Image size 1240x1240; wide-field fundus image from infant ROP screening
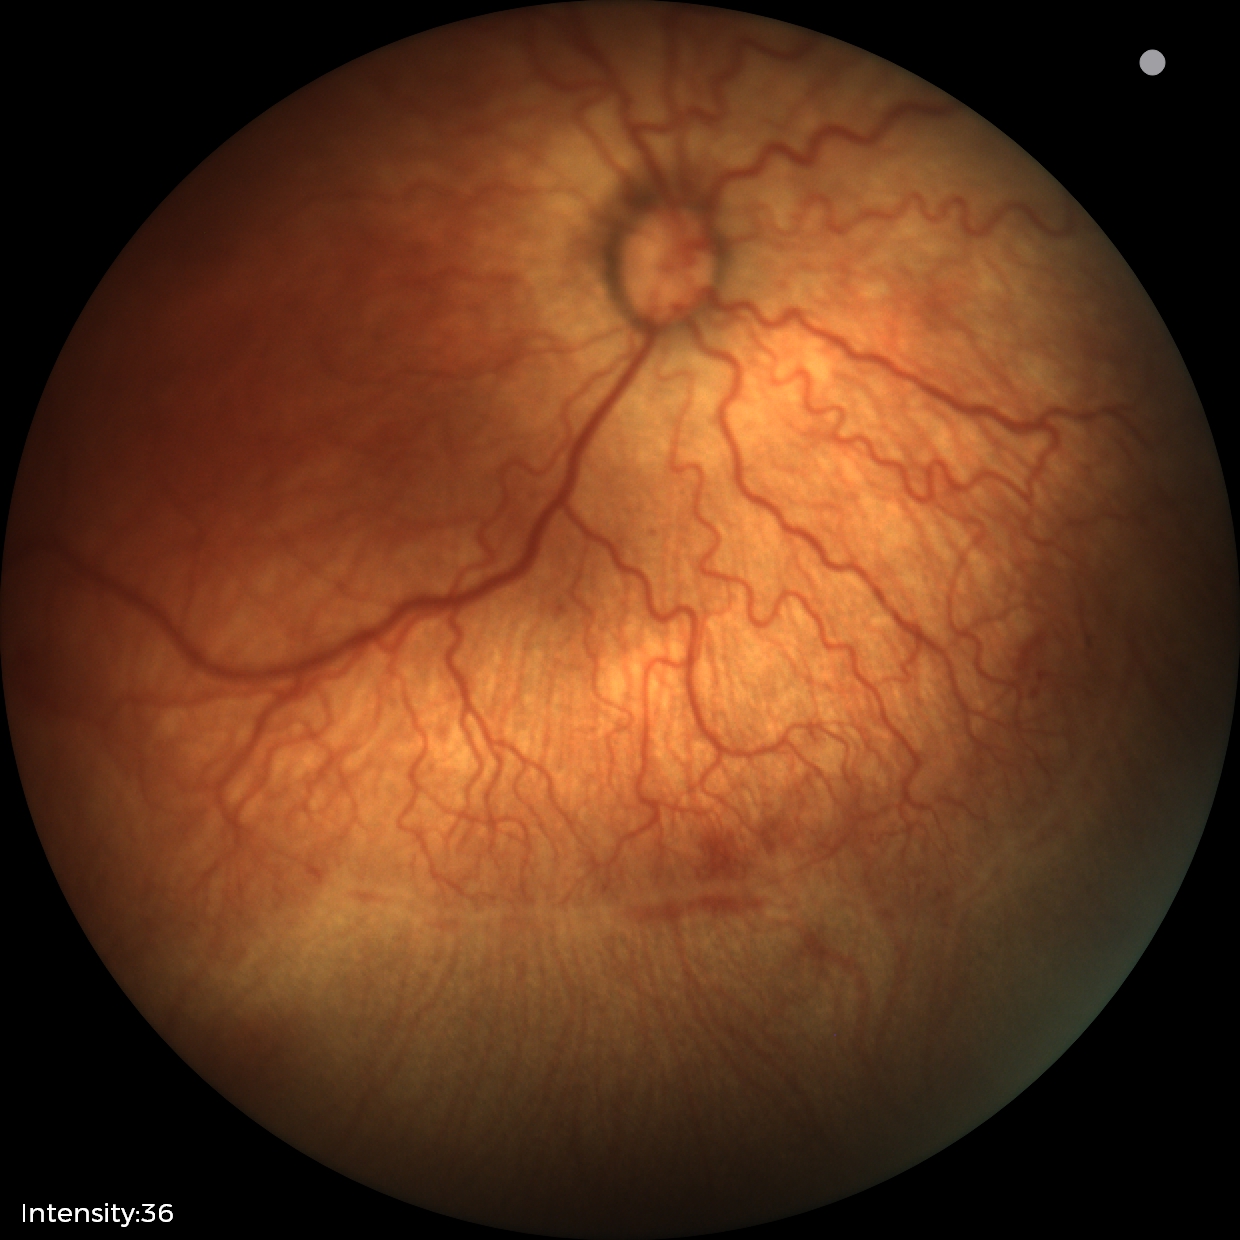 Diagnosis from this screening exam: ROP stage 2.